Macula-centered field · Topcon TRC-NW8 · color fundus image — 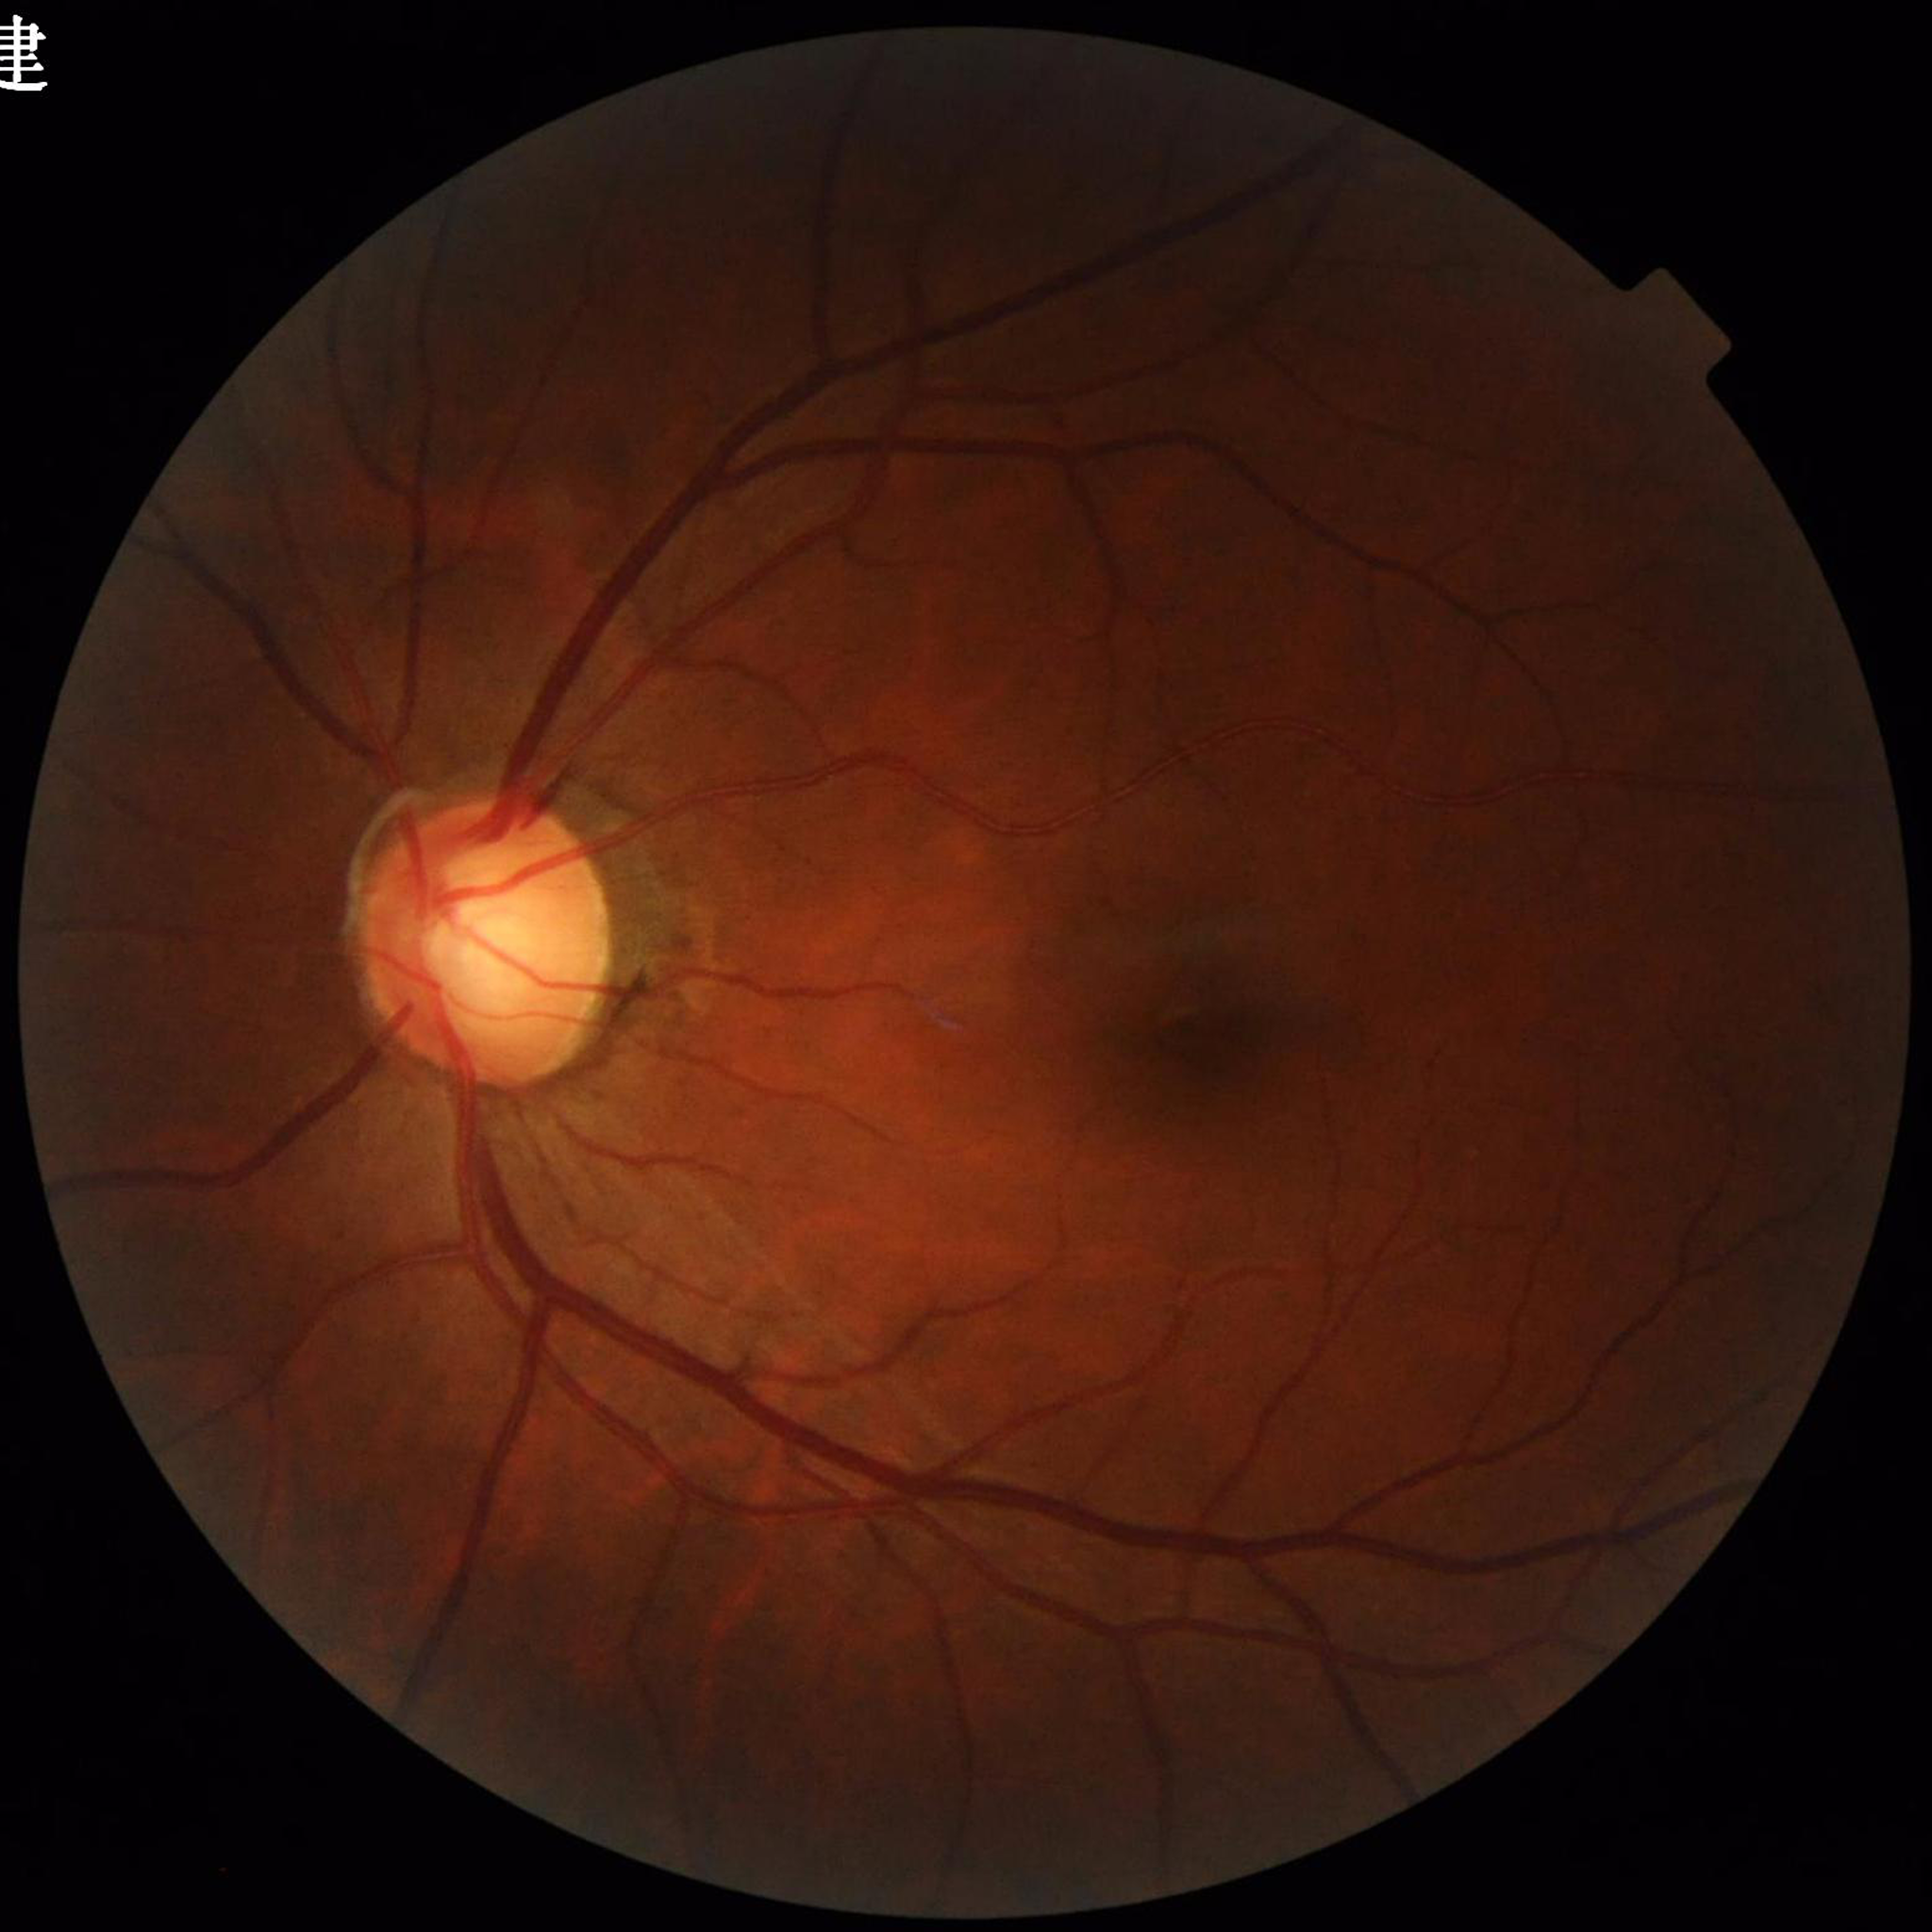 Disease class = glaucoma.